Optic disc photograph
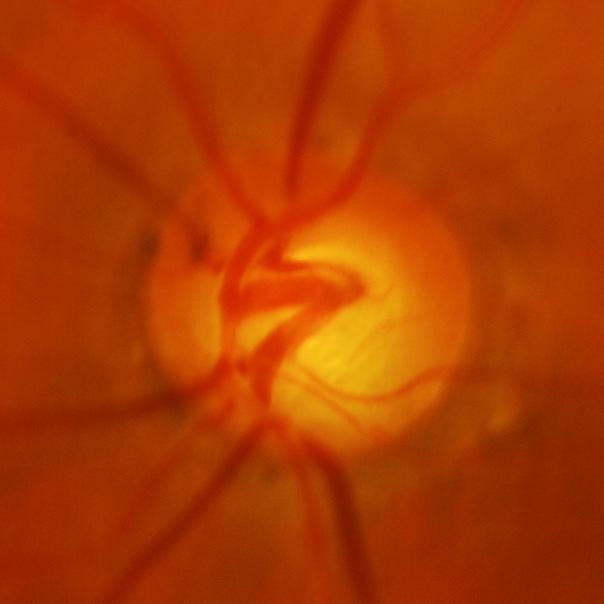
Q: Is glaucoma present?
A: Glaucomatous findings.